45 degree fundus photograph. Nonmydriatic — 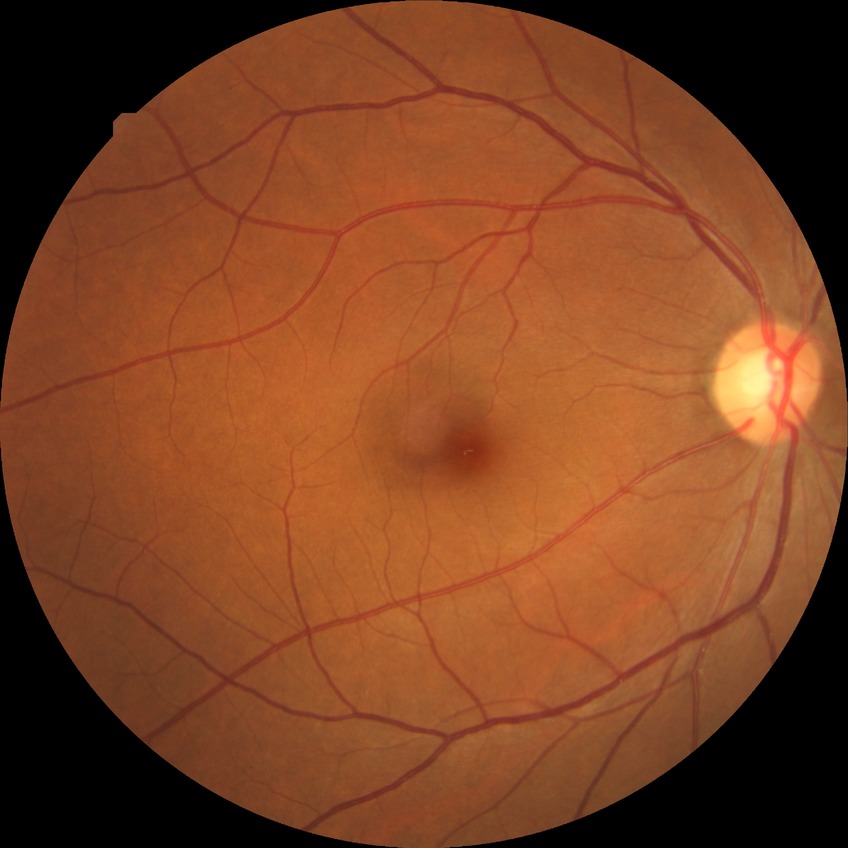 Findings:
– diabetic retinopathy (DR) — NDR (no diabetic retinopathy)